CFP — 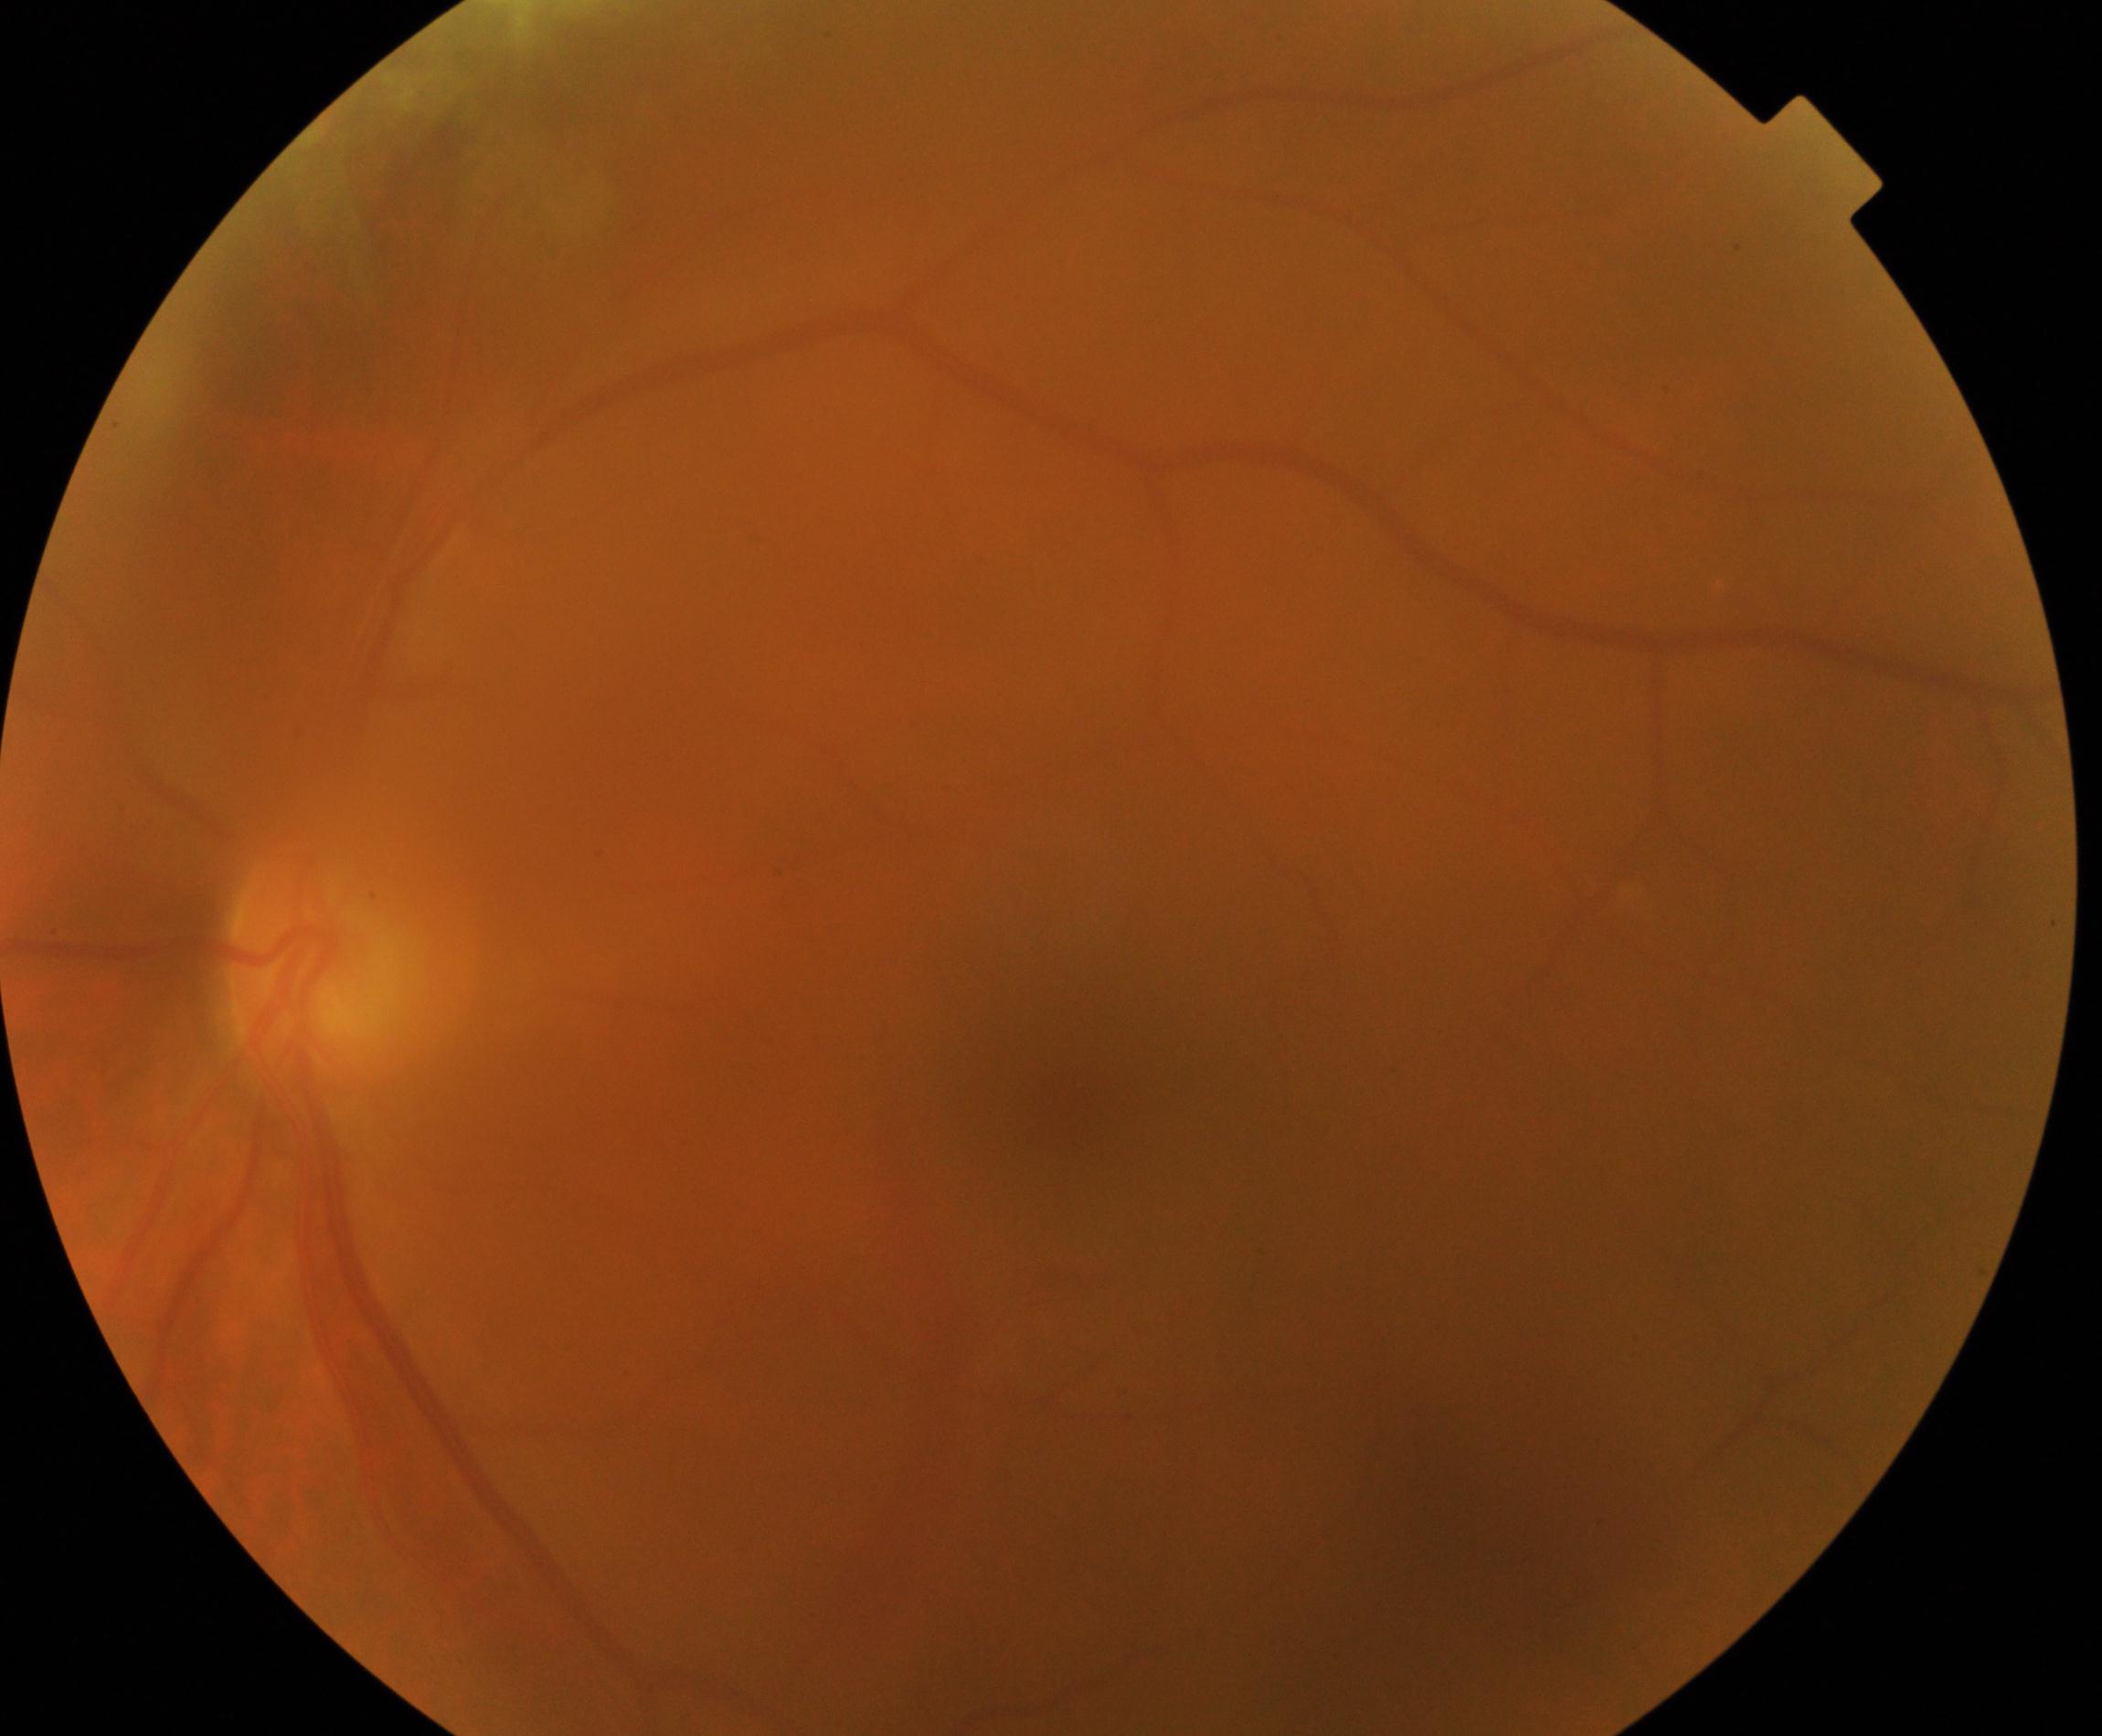 Gradability: blurred, more than half the field obscured. Proliferative diabetic retinopathy: negative.